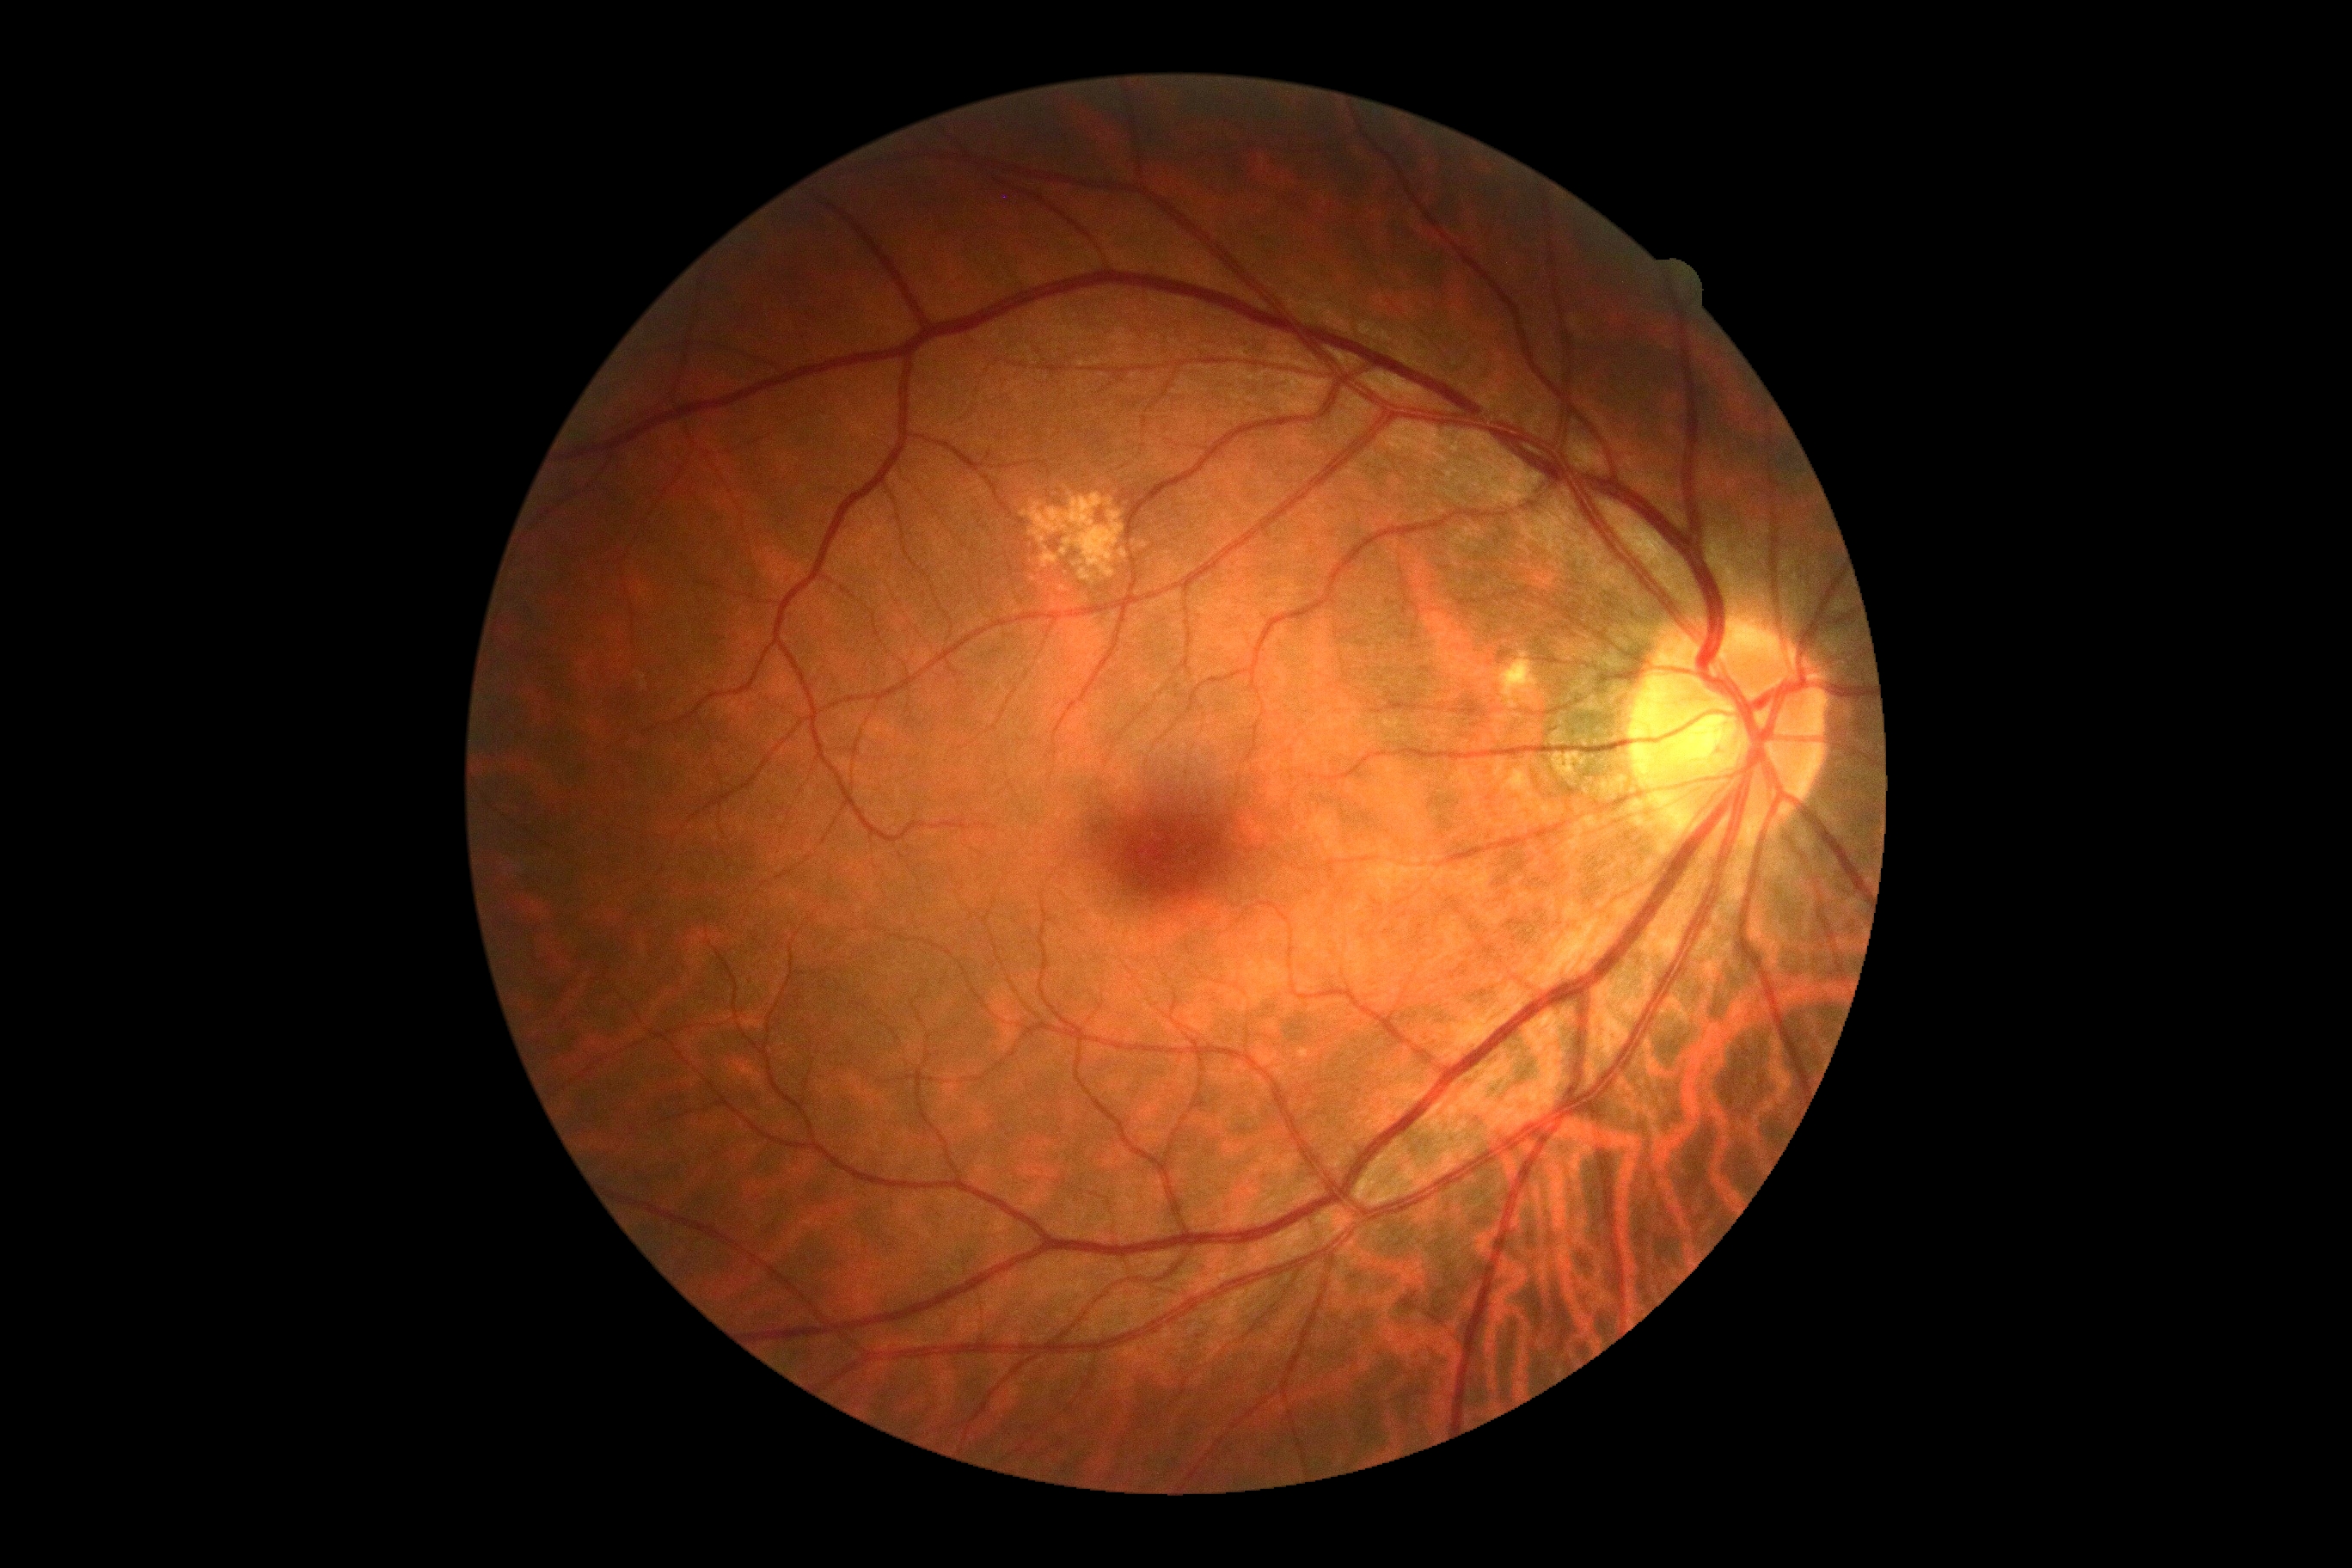
• DR stage: grade 0 (no apparent retinopathy)